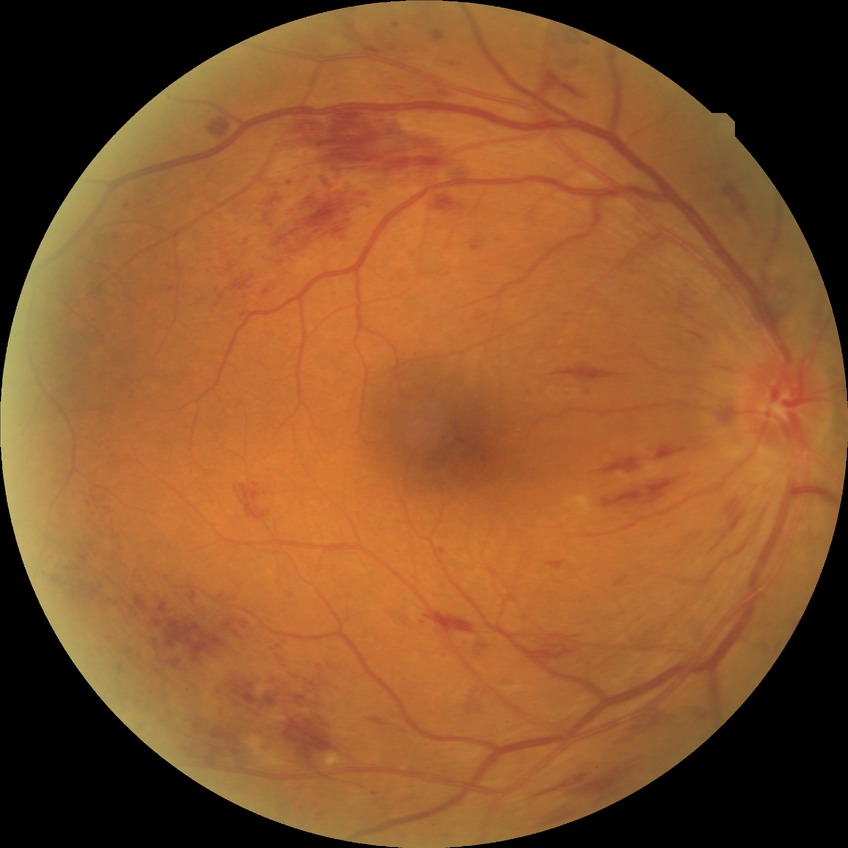 Annotations:
* DR class — non-proliferative diabetic retinopathy
* diabetic retinopathy (DR) — PPDR (pre-proliferative diabetic retinopathy)